RetCam wide-field infant fundus image: 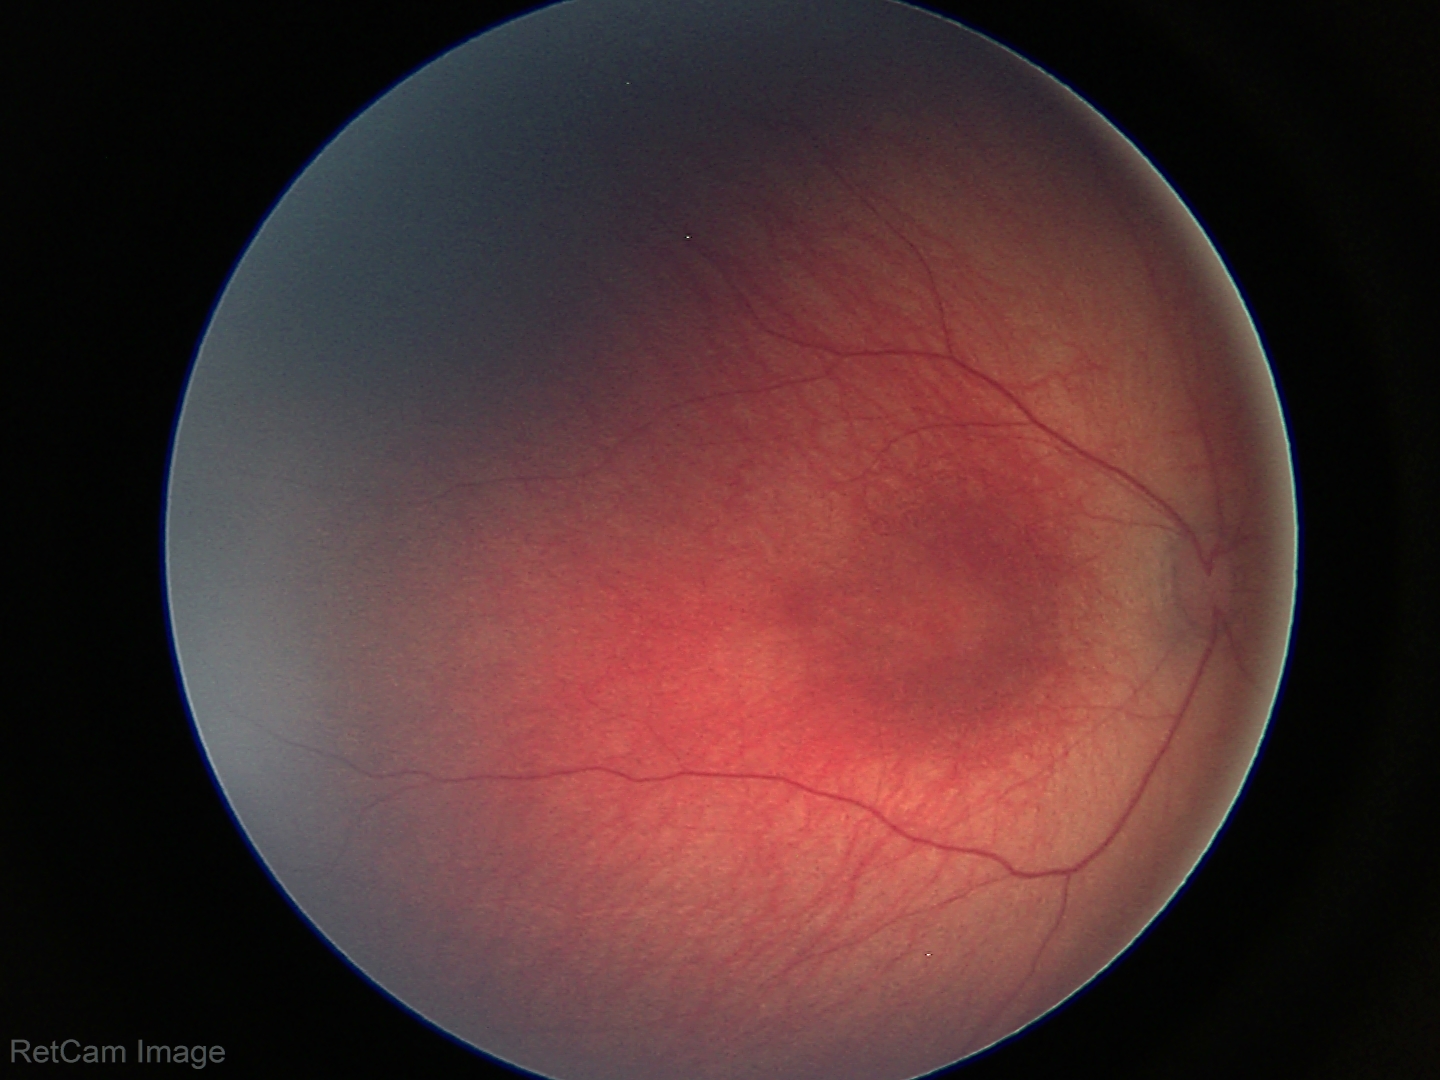

Screening examination with no abnormal retinal findings.